Optic disc region of a color fundus photo.
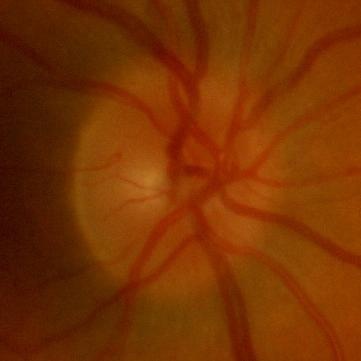

Glaucoma assessment = no glaucomatous optic neuropathy.